Camera: NIDEK AFC-230 · 848 x 848 pixels · no pharmacologic dilation · color fundus image · modified Davis classification: 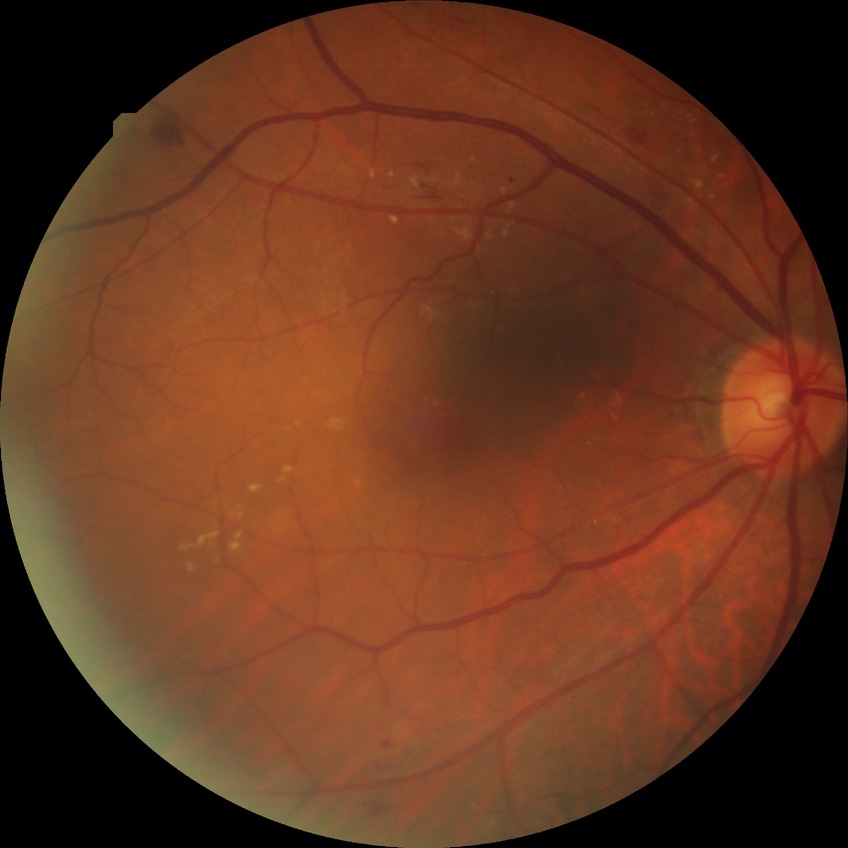 Diabetic retinopathy (DR) is SDR (simple diabetic retinopathy).